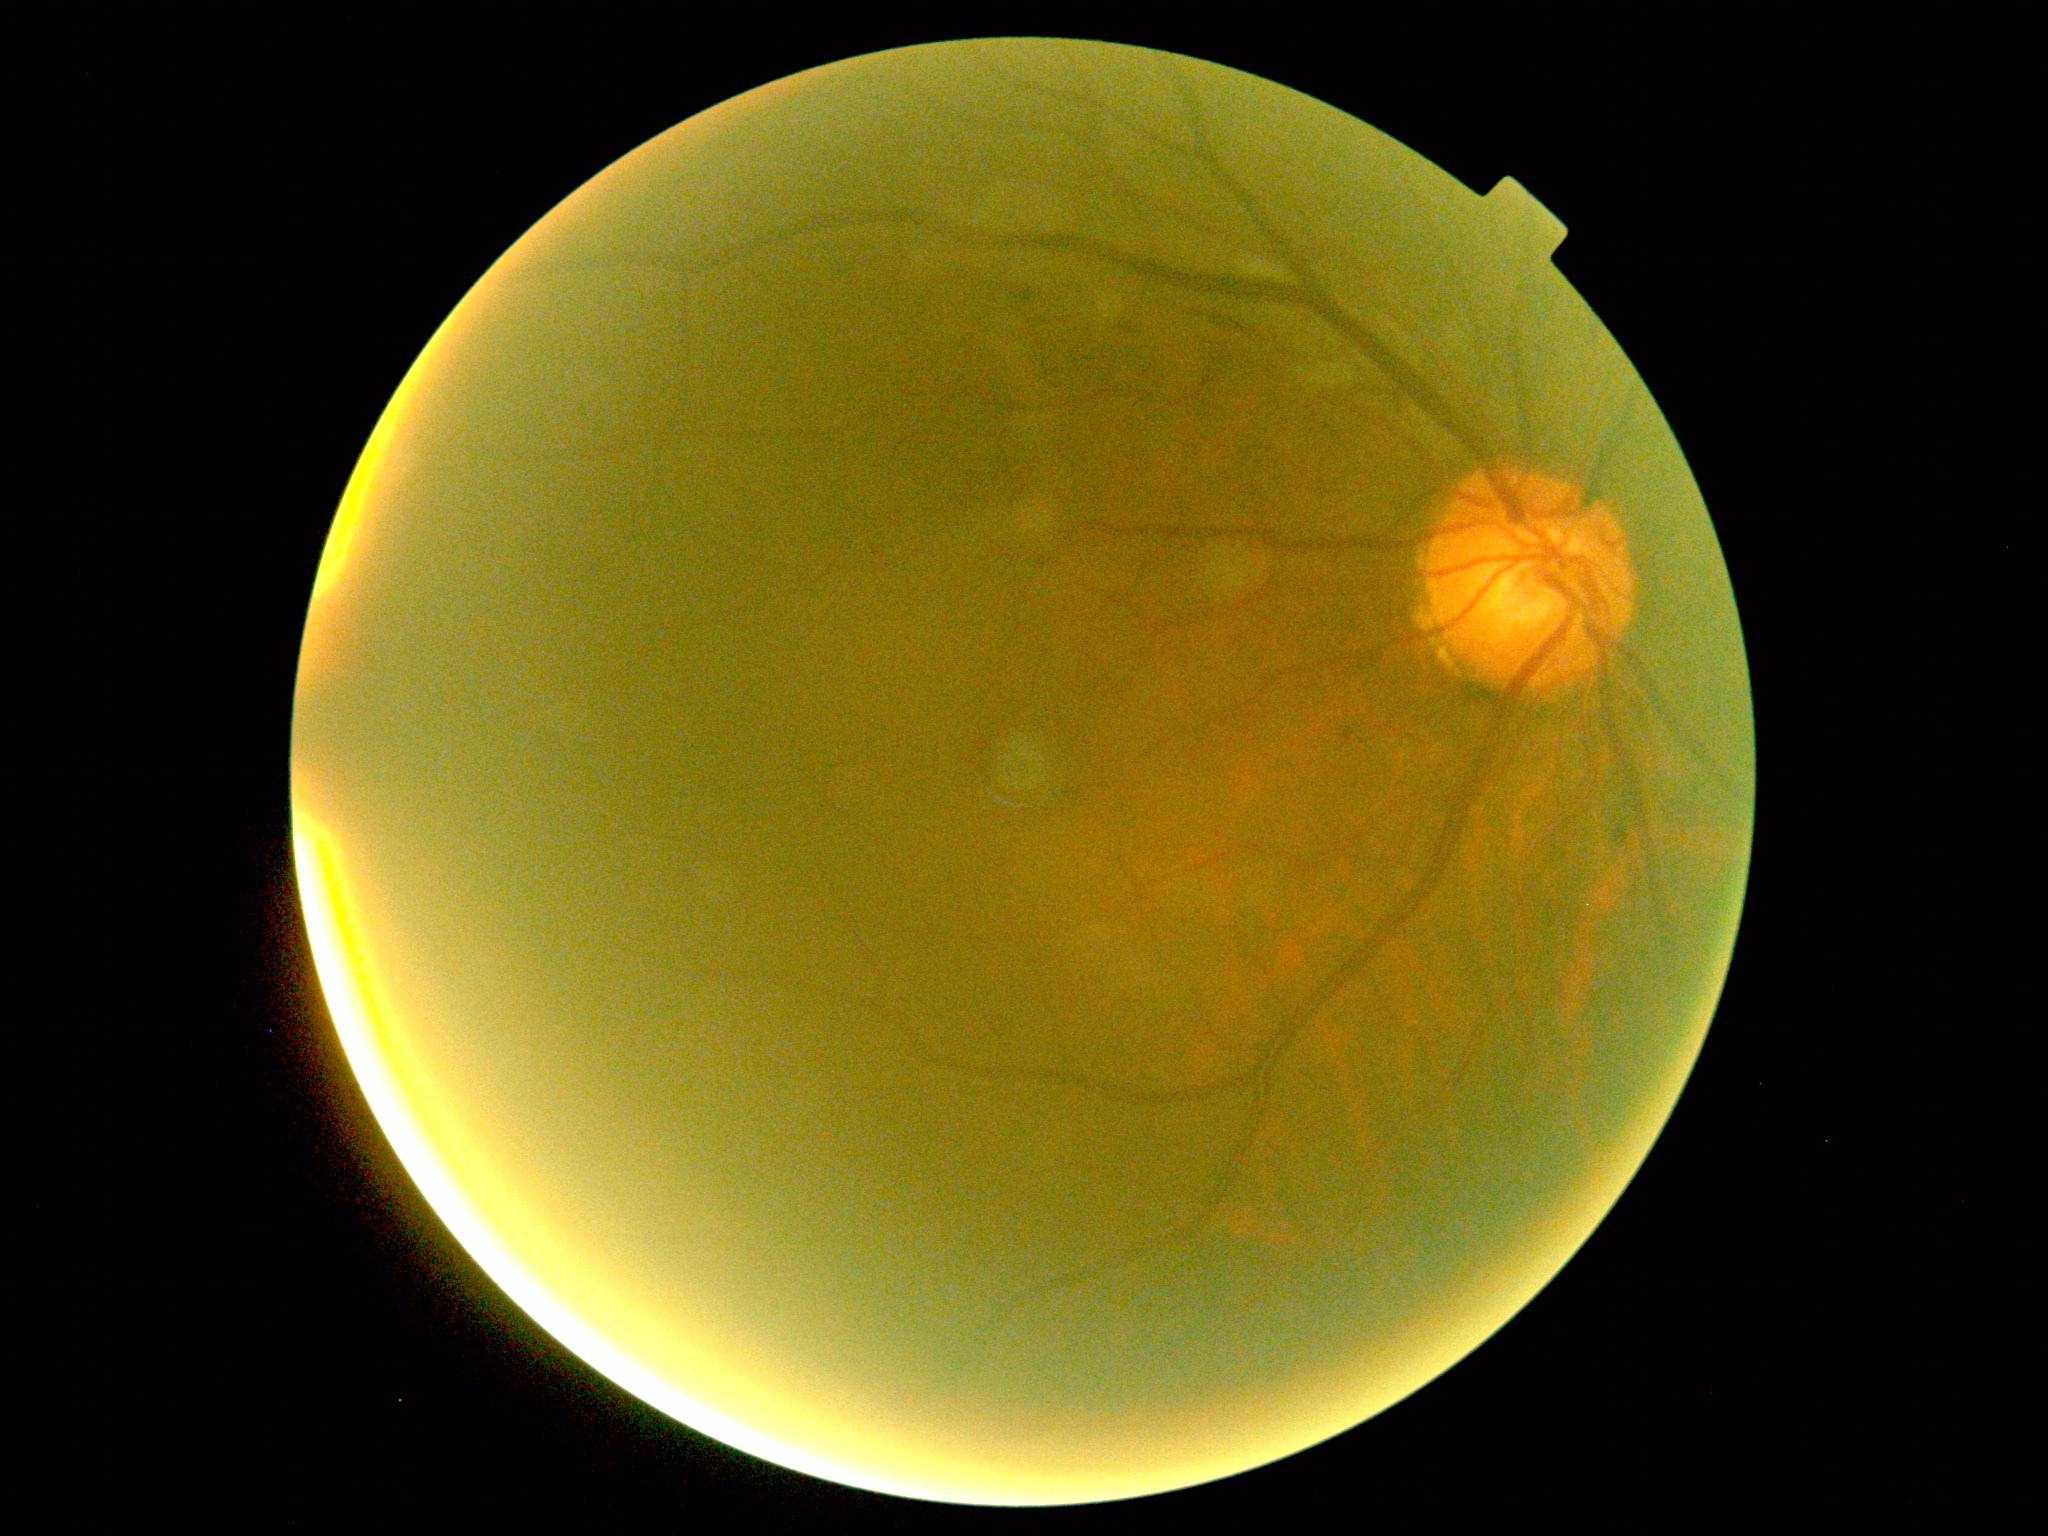
Annotations:
• retinopathy grade — 2/4
• DR class — non-proliferative diabetic retinopathy